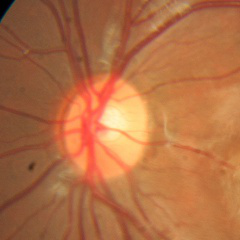

Findings consistent with no glaucomatous changes.